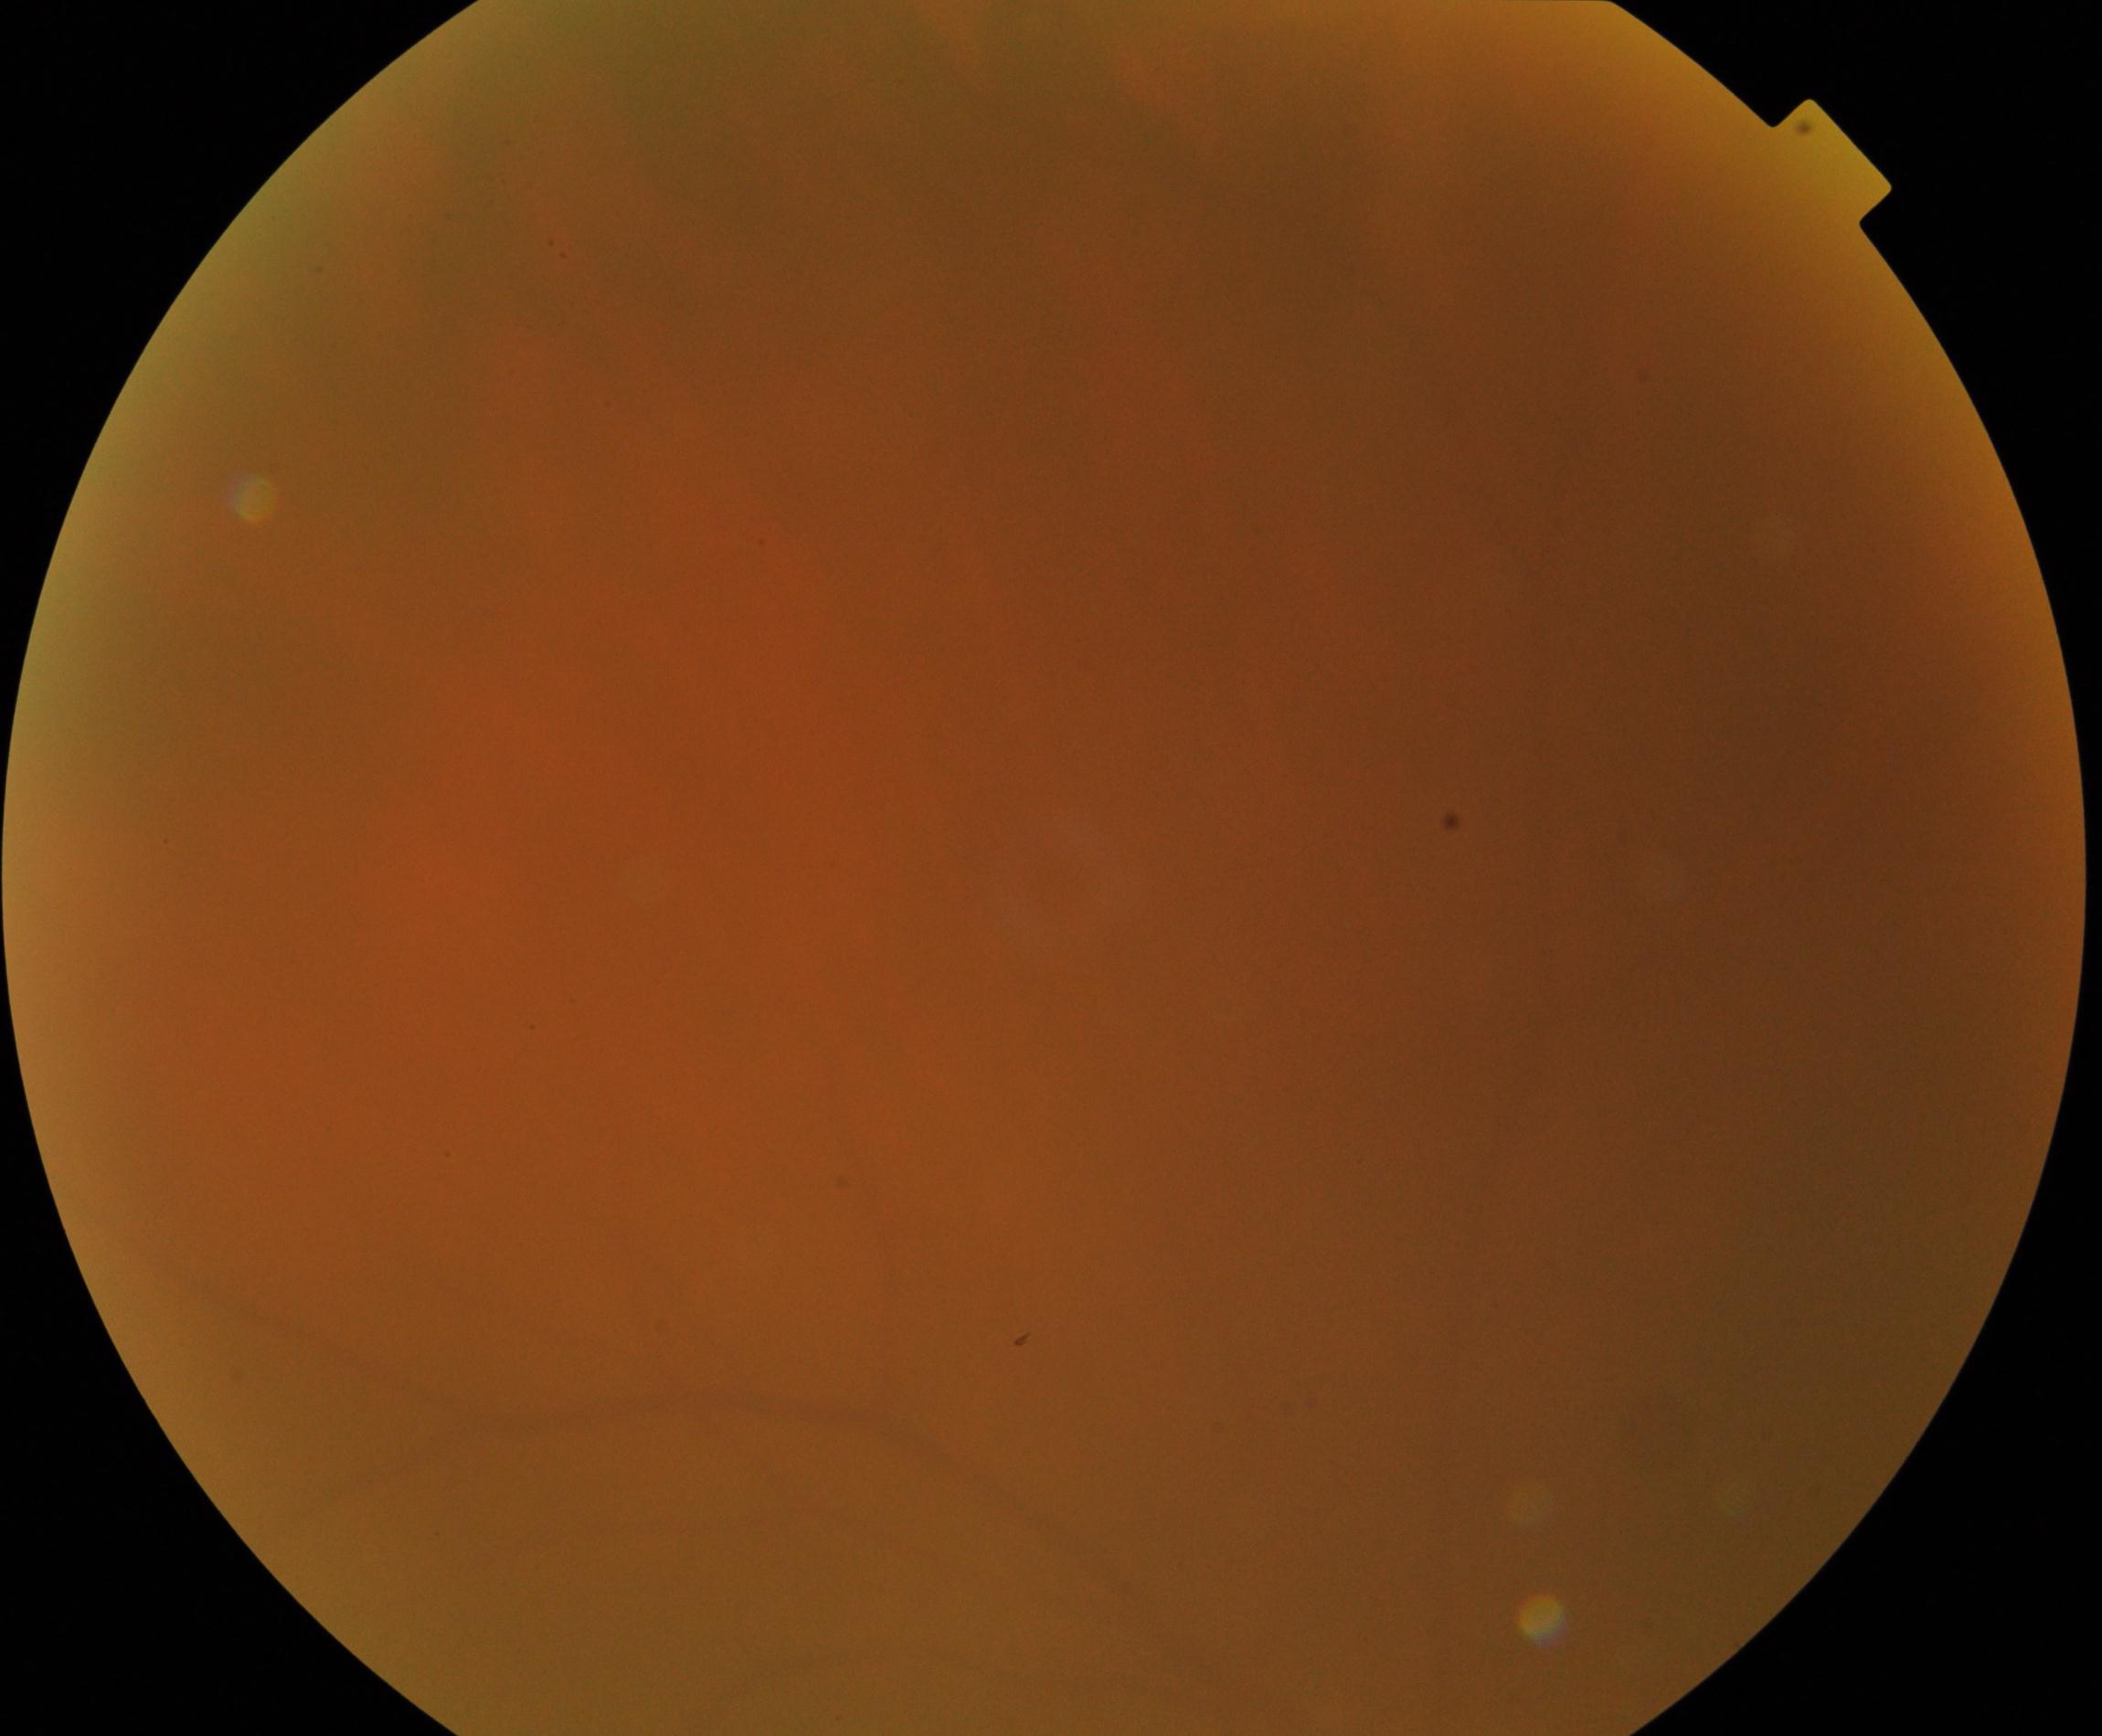 Gradability: blurred, more than half the field obscured. Proliferative diabetic retinopathy: no evidence.